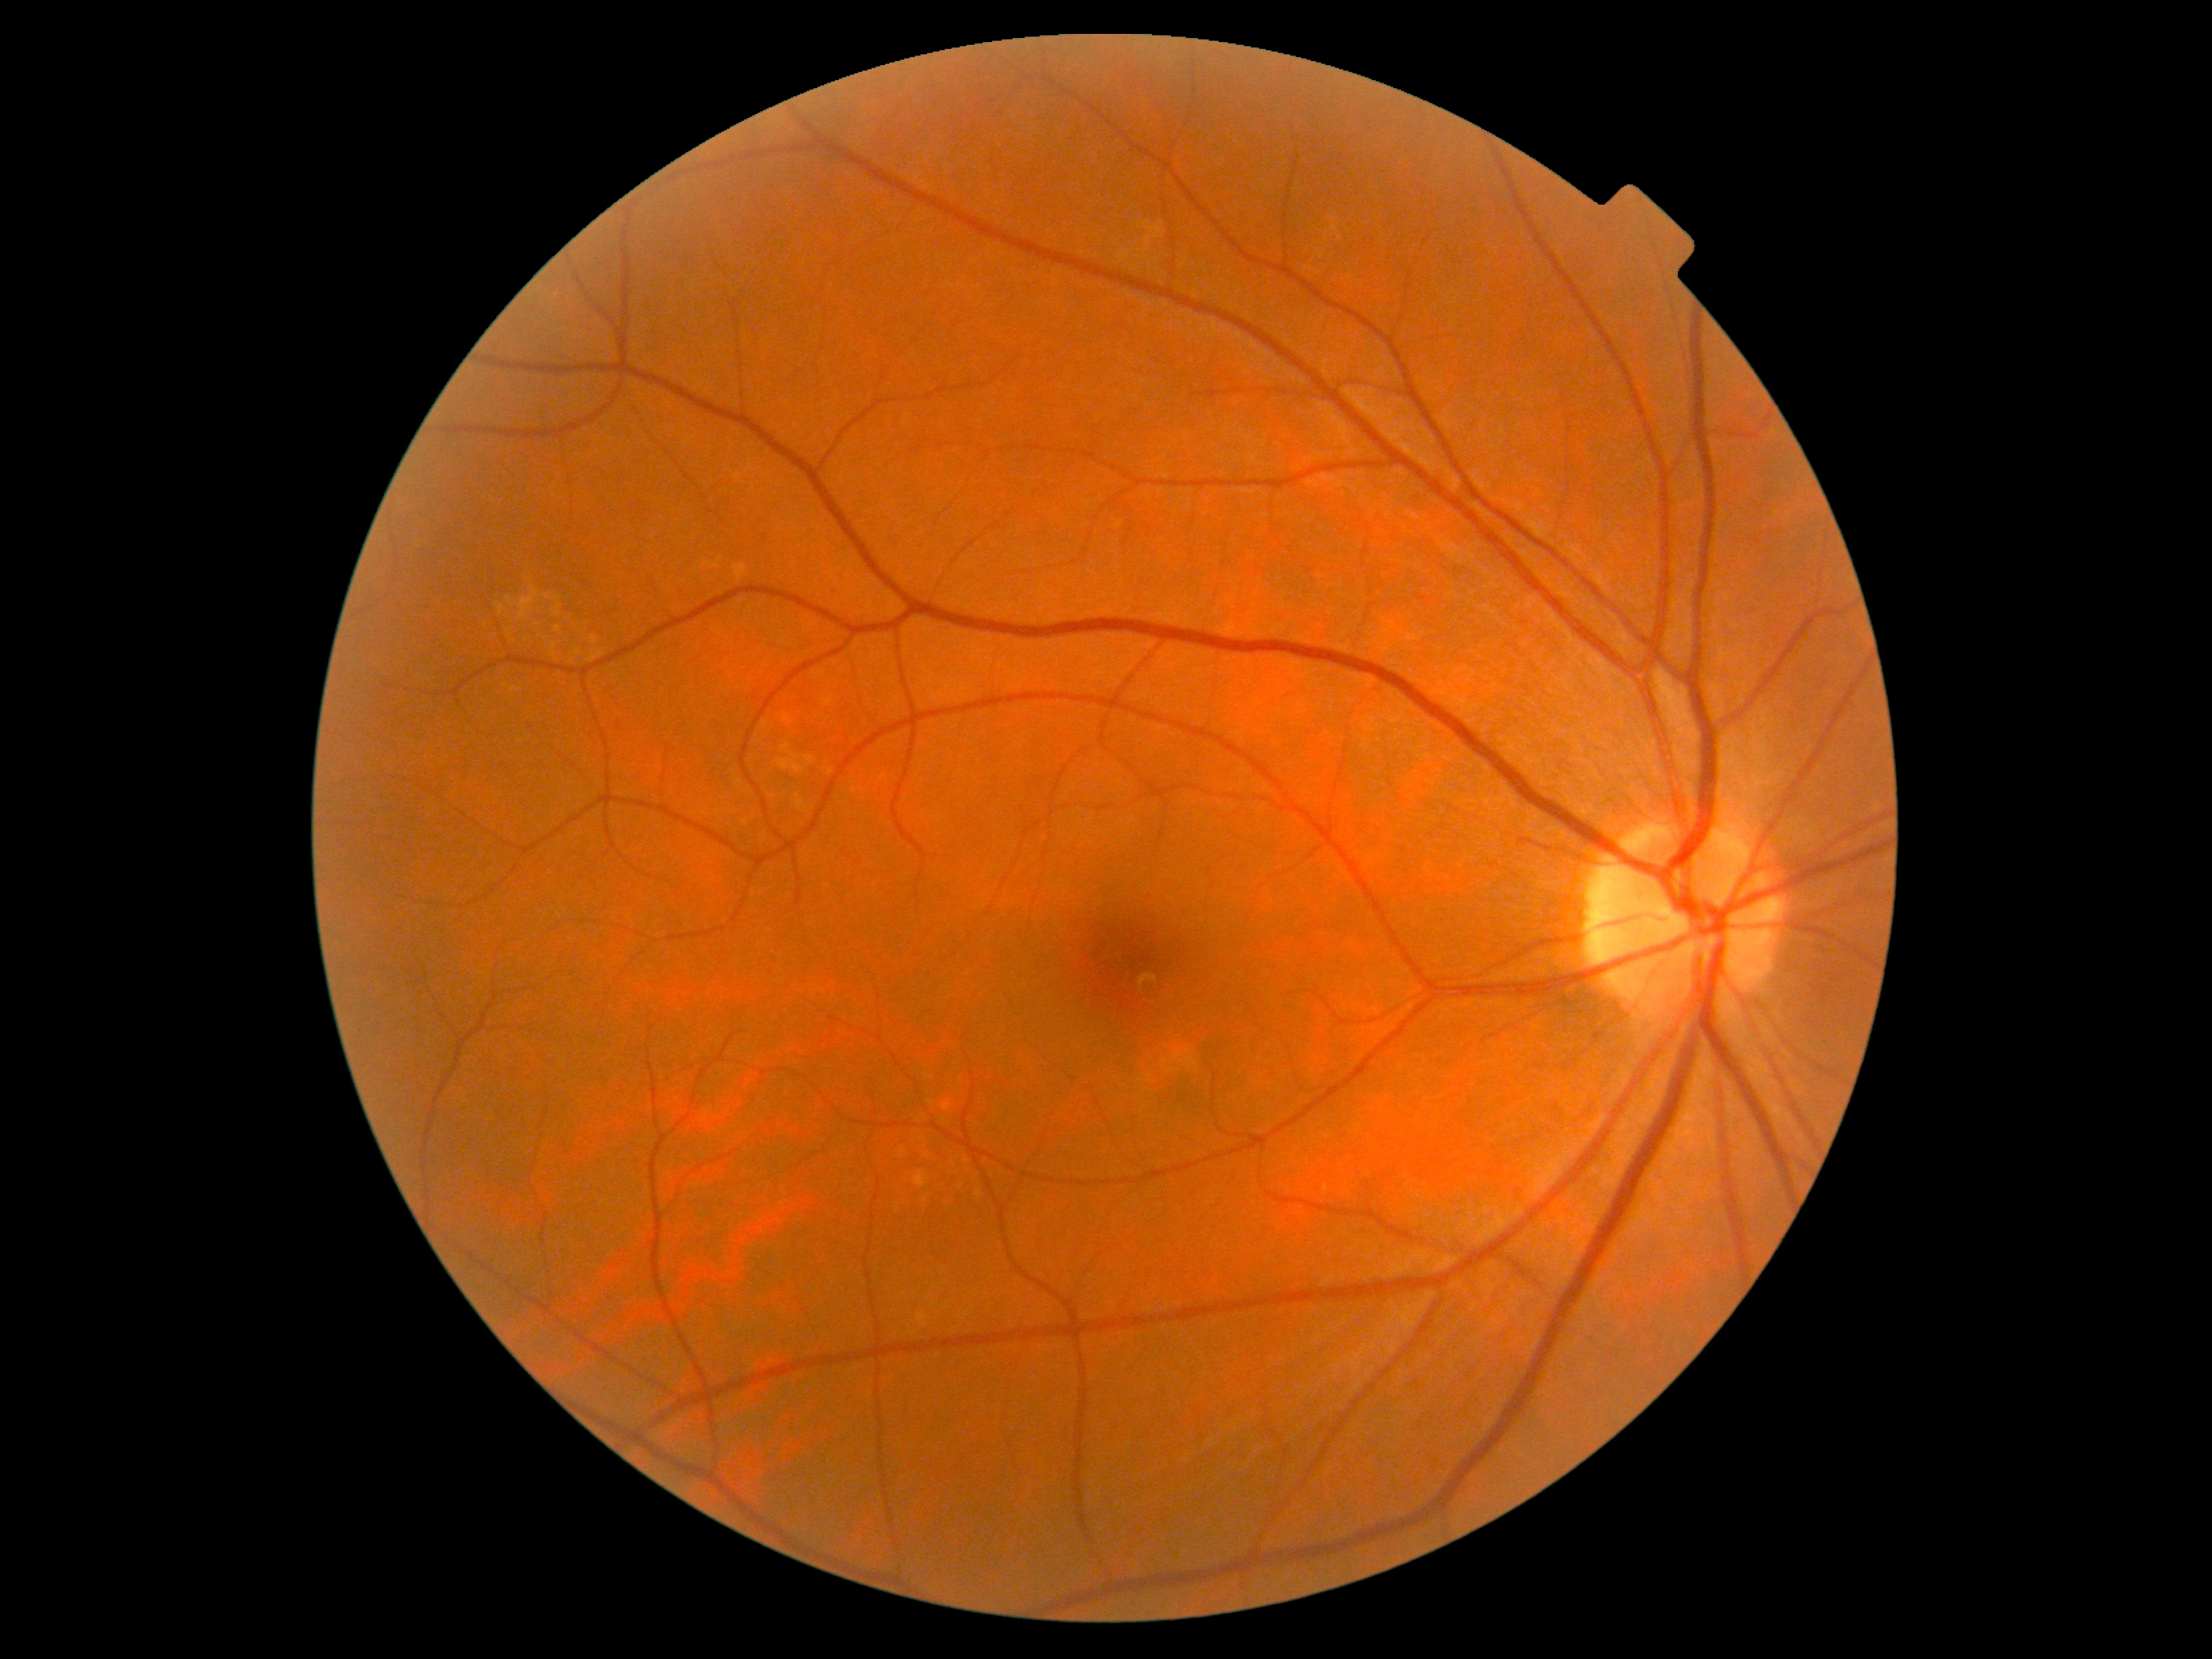 DR stage: 0/4.
No apparent diabetic retinopathy.